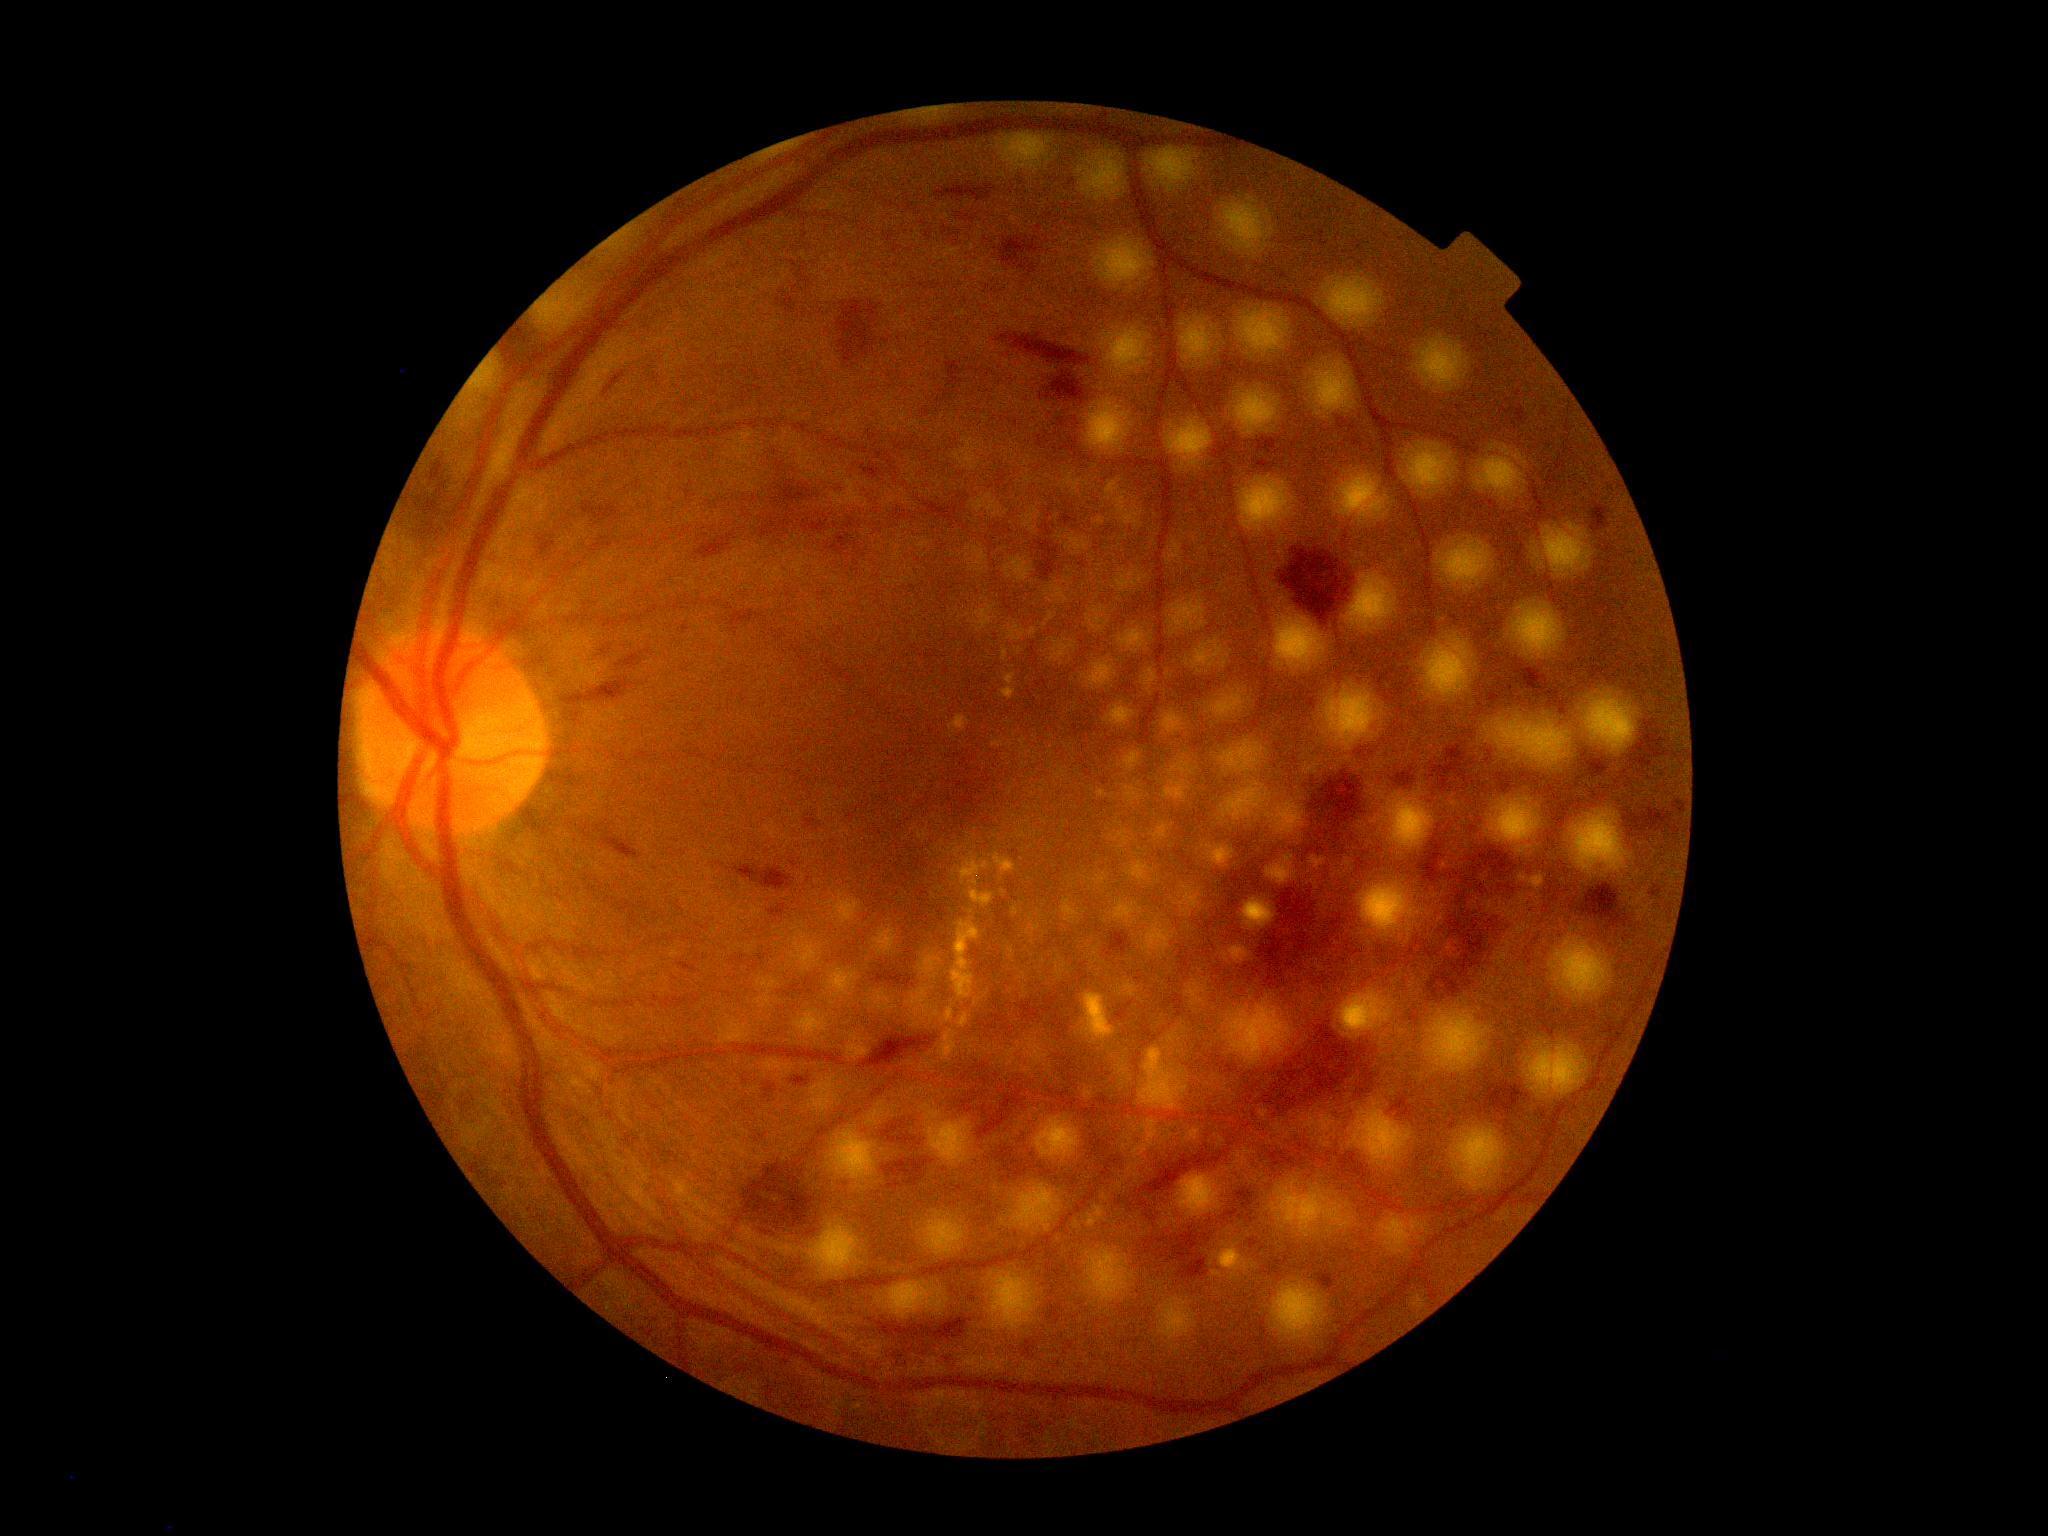
DR severity is grade 3 (severe NPDR) — more than 20 intraretinal hemorrhages in each of 4 quadrants, definite venous beading in 2 or more quadrants, or prominent intraretinal microvascular abnormalities in 1 or more quadrants, with no signs of proliferative retinopathy.